Fundus photo · camera: Remidio Fundus on Phone: 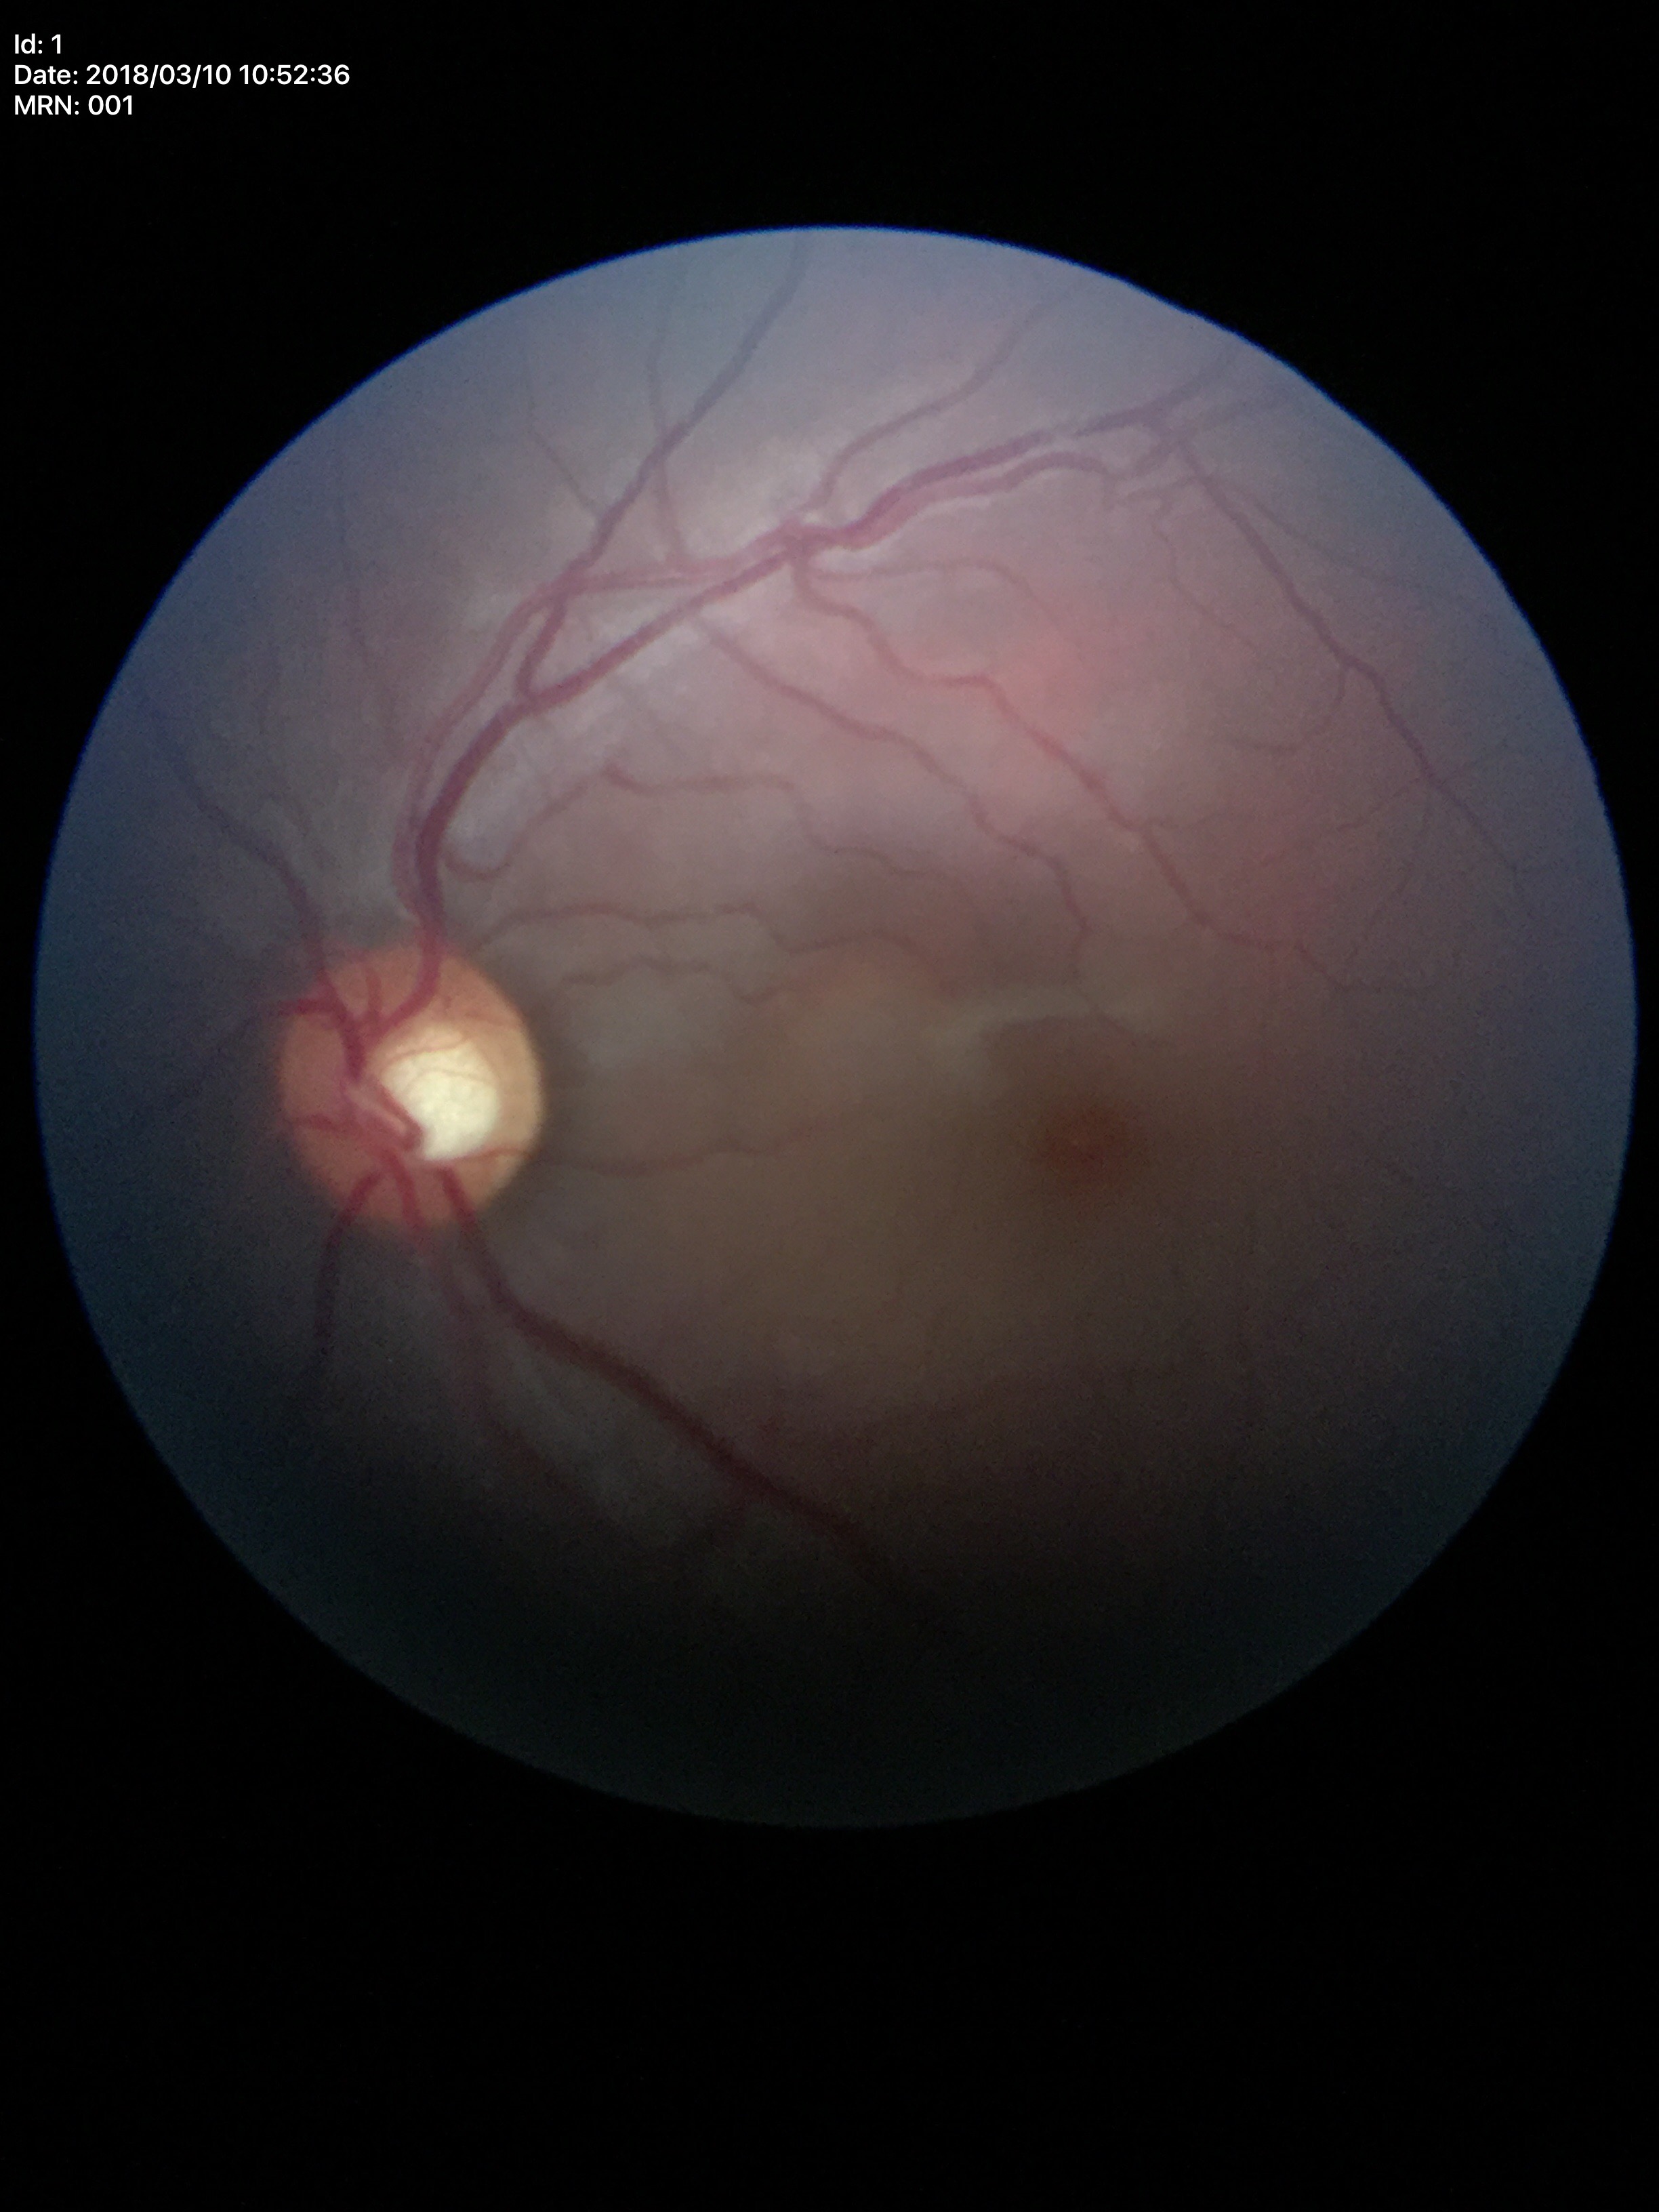
Glaucoma impression = no suspicious findings (1/5 graders called glaucoma suspect); vertical CDR = 0.56.